Diabetic retinopathy graded by the modified Davis classification · 45° FOV
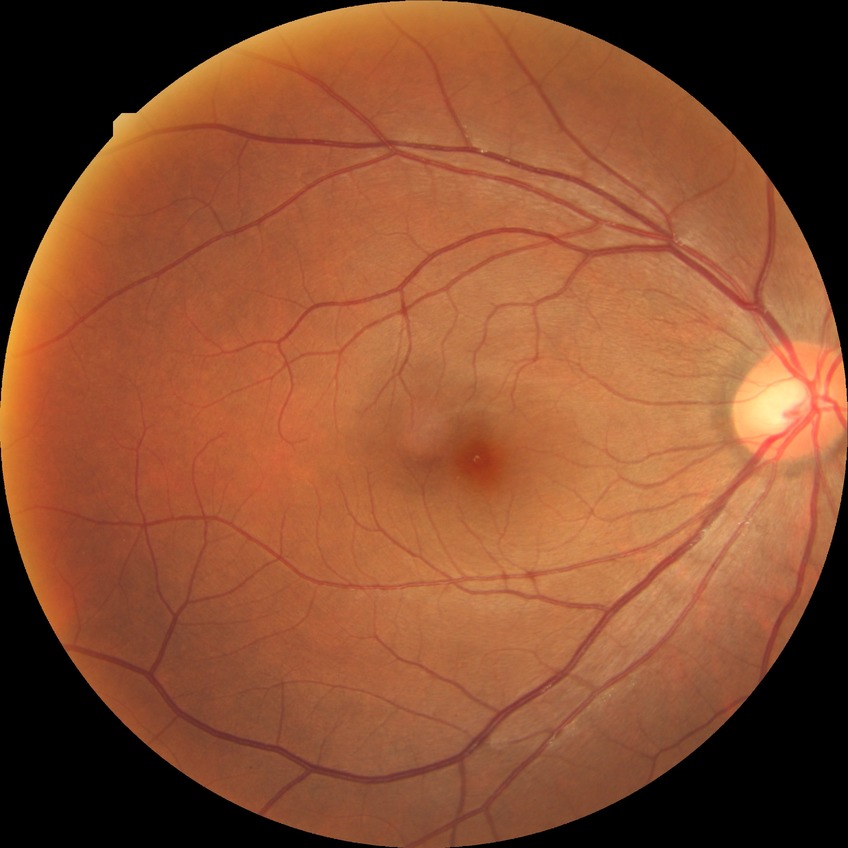

Diabetic retinopathy (DR) is NDR (no diabetic retinopathy).